FOV: 45 degrees:
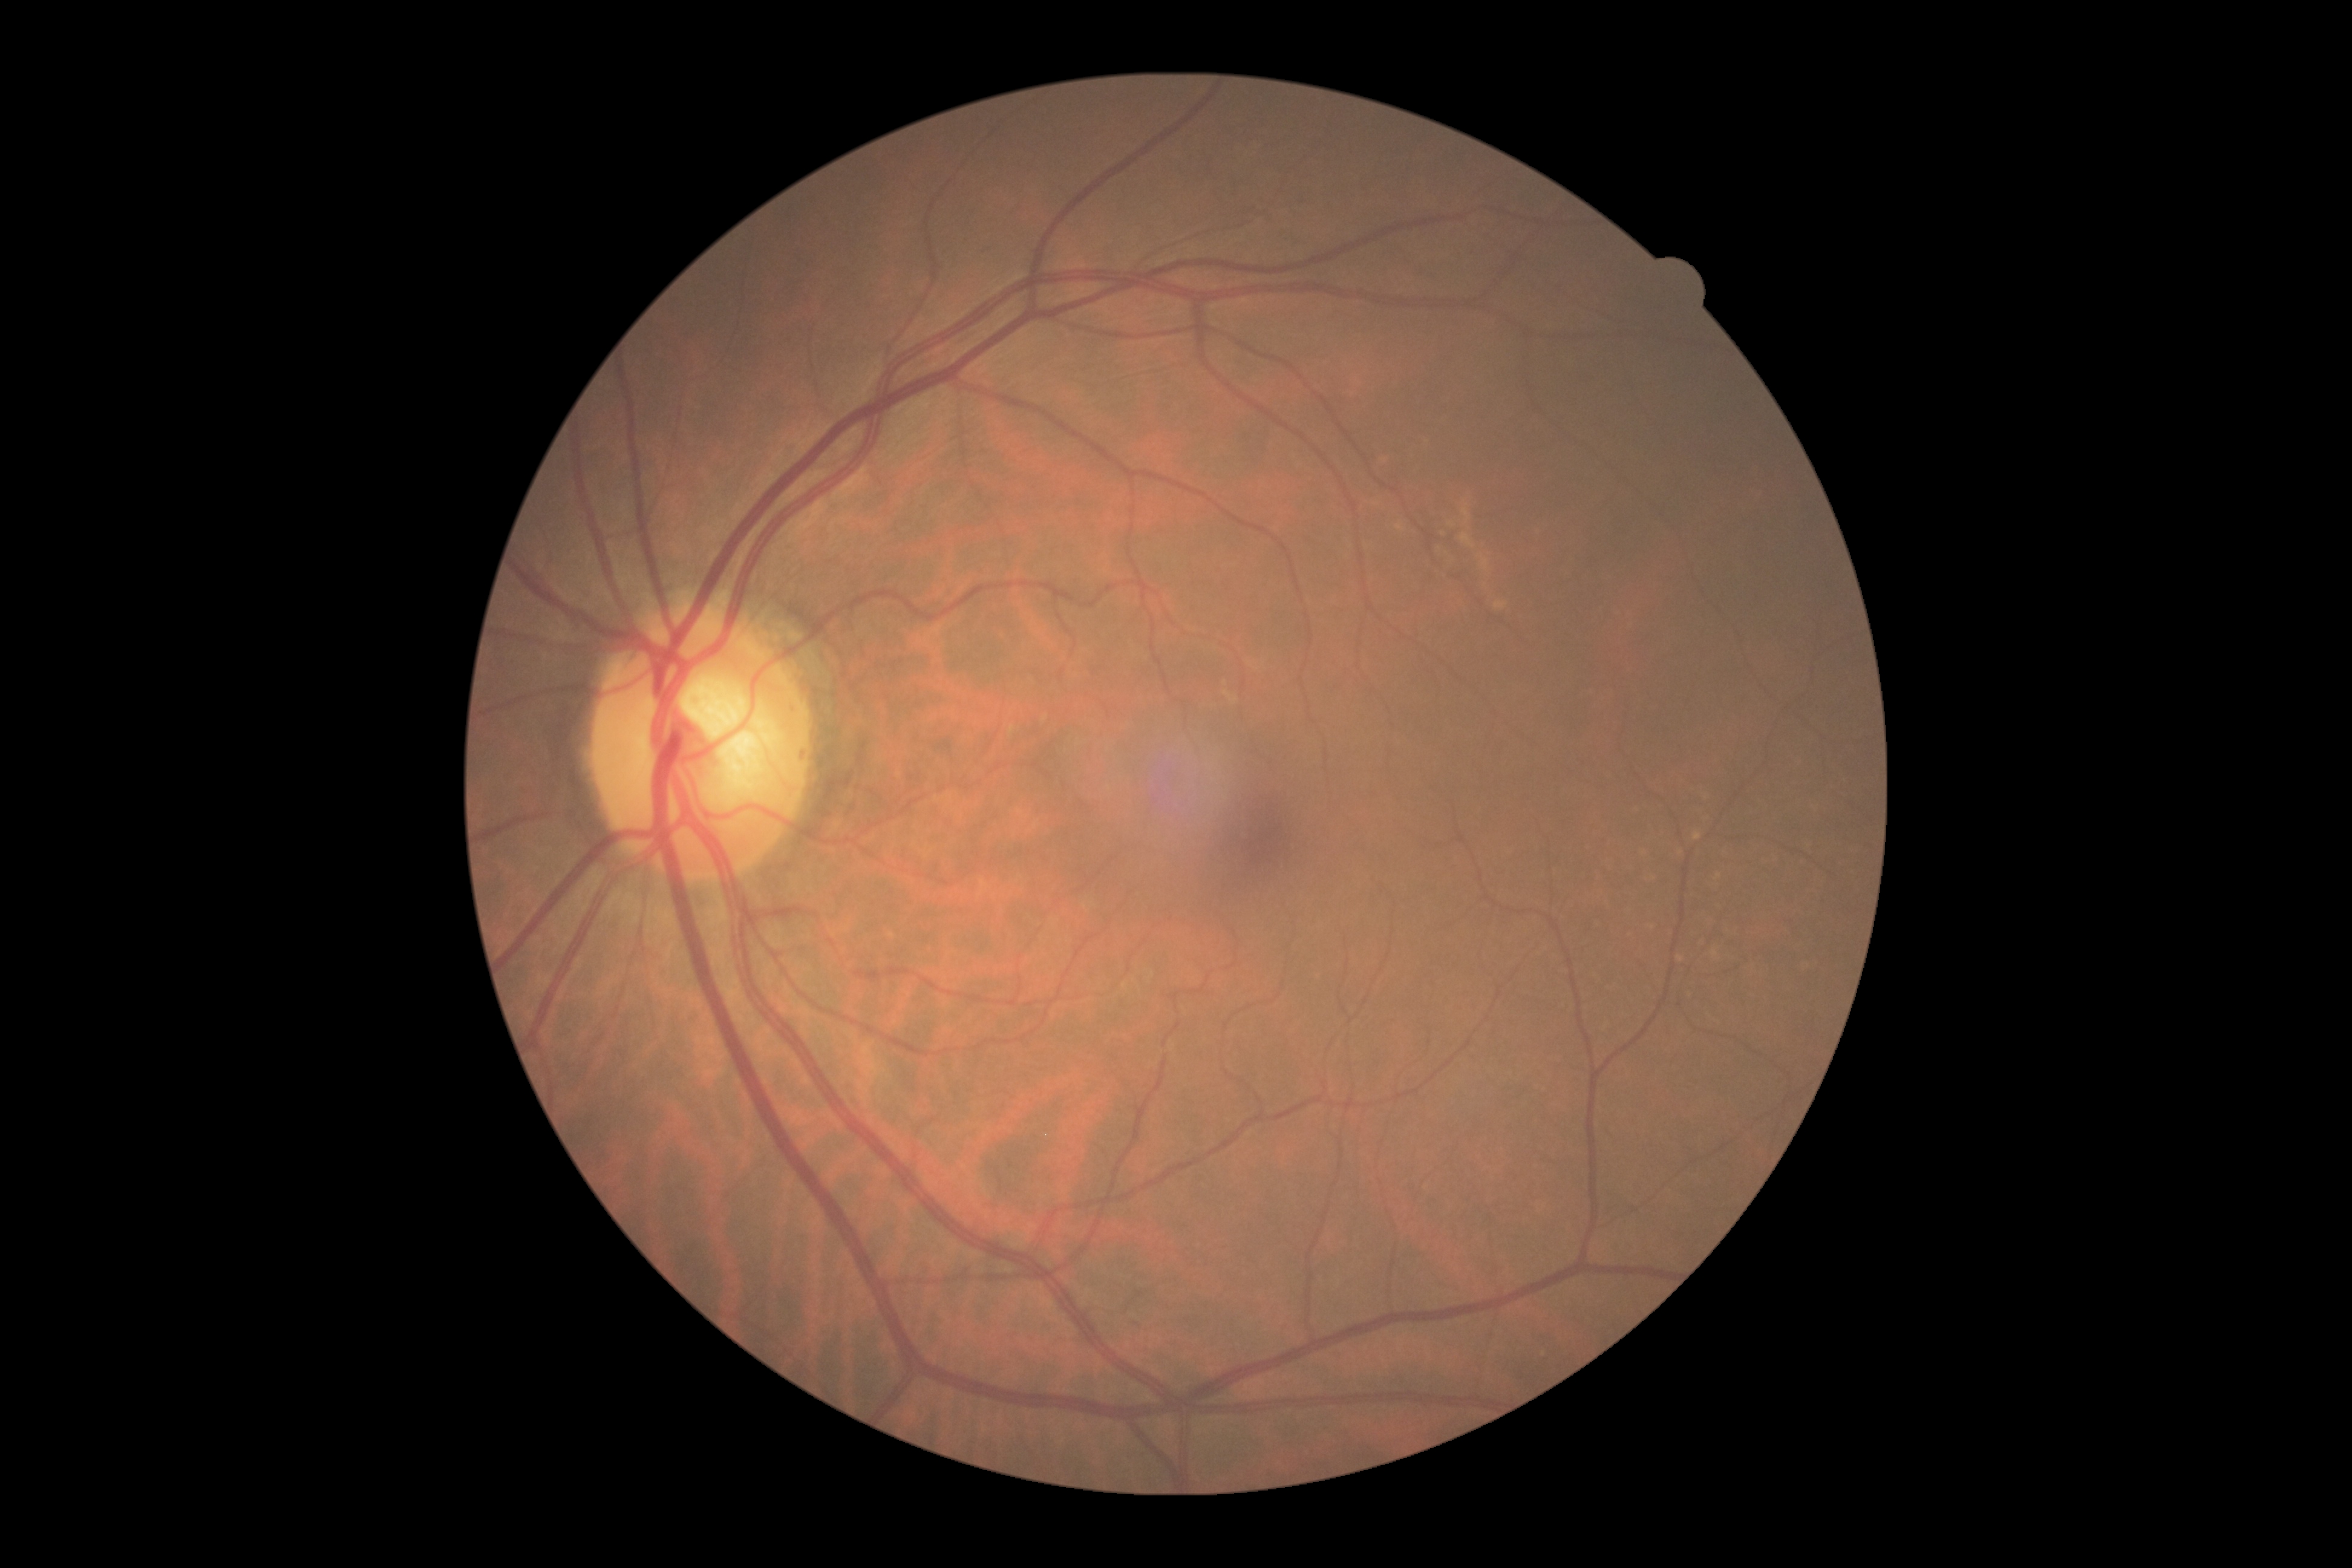

  dr_grade: grade 0
  dr_impression: negative for DR